Portable fundus photograph.
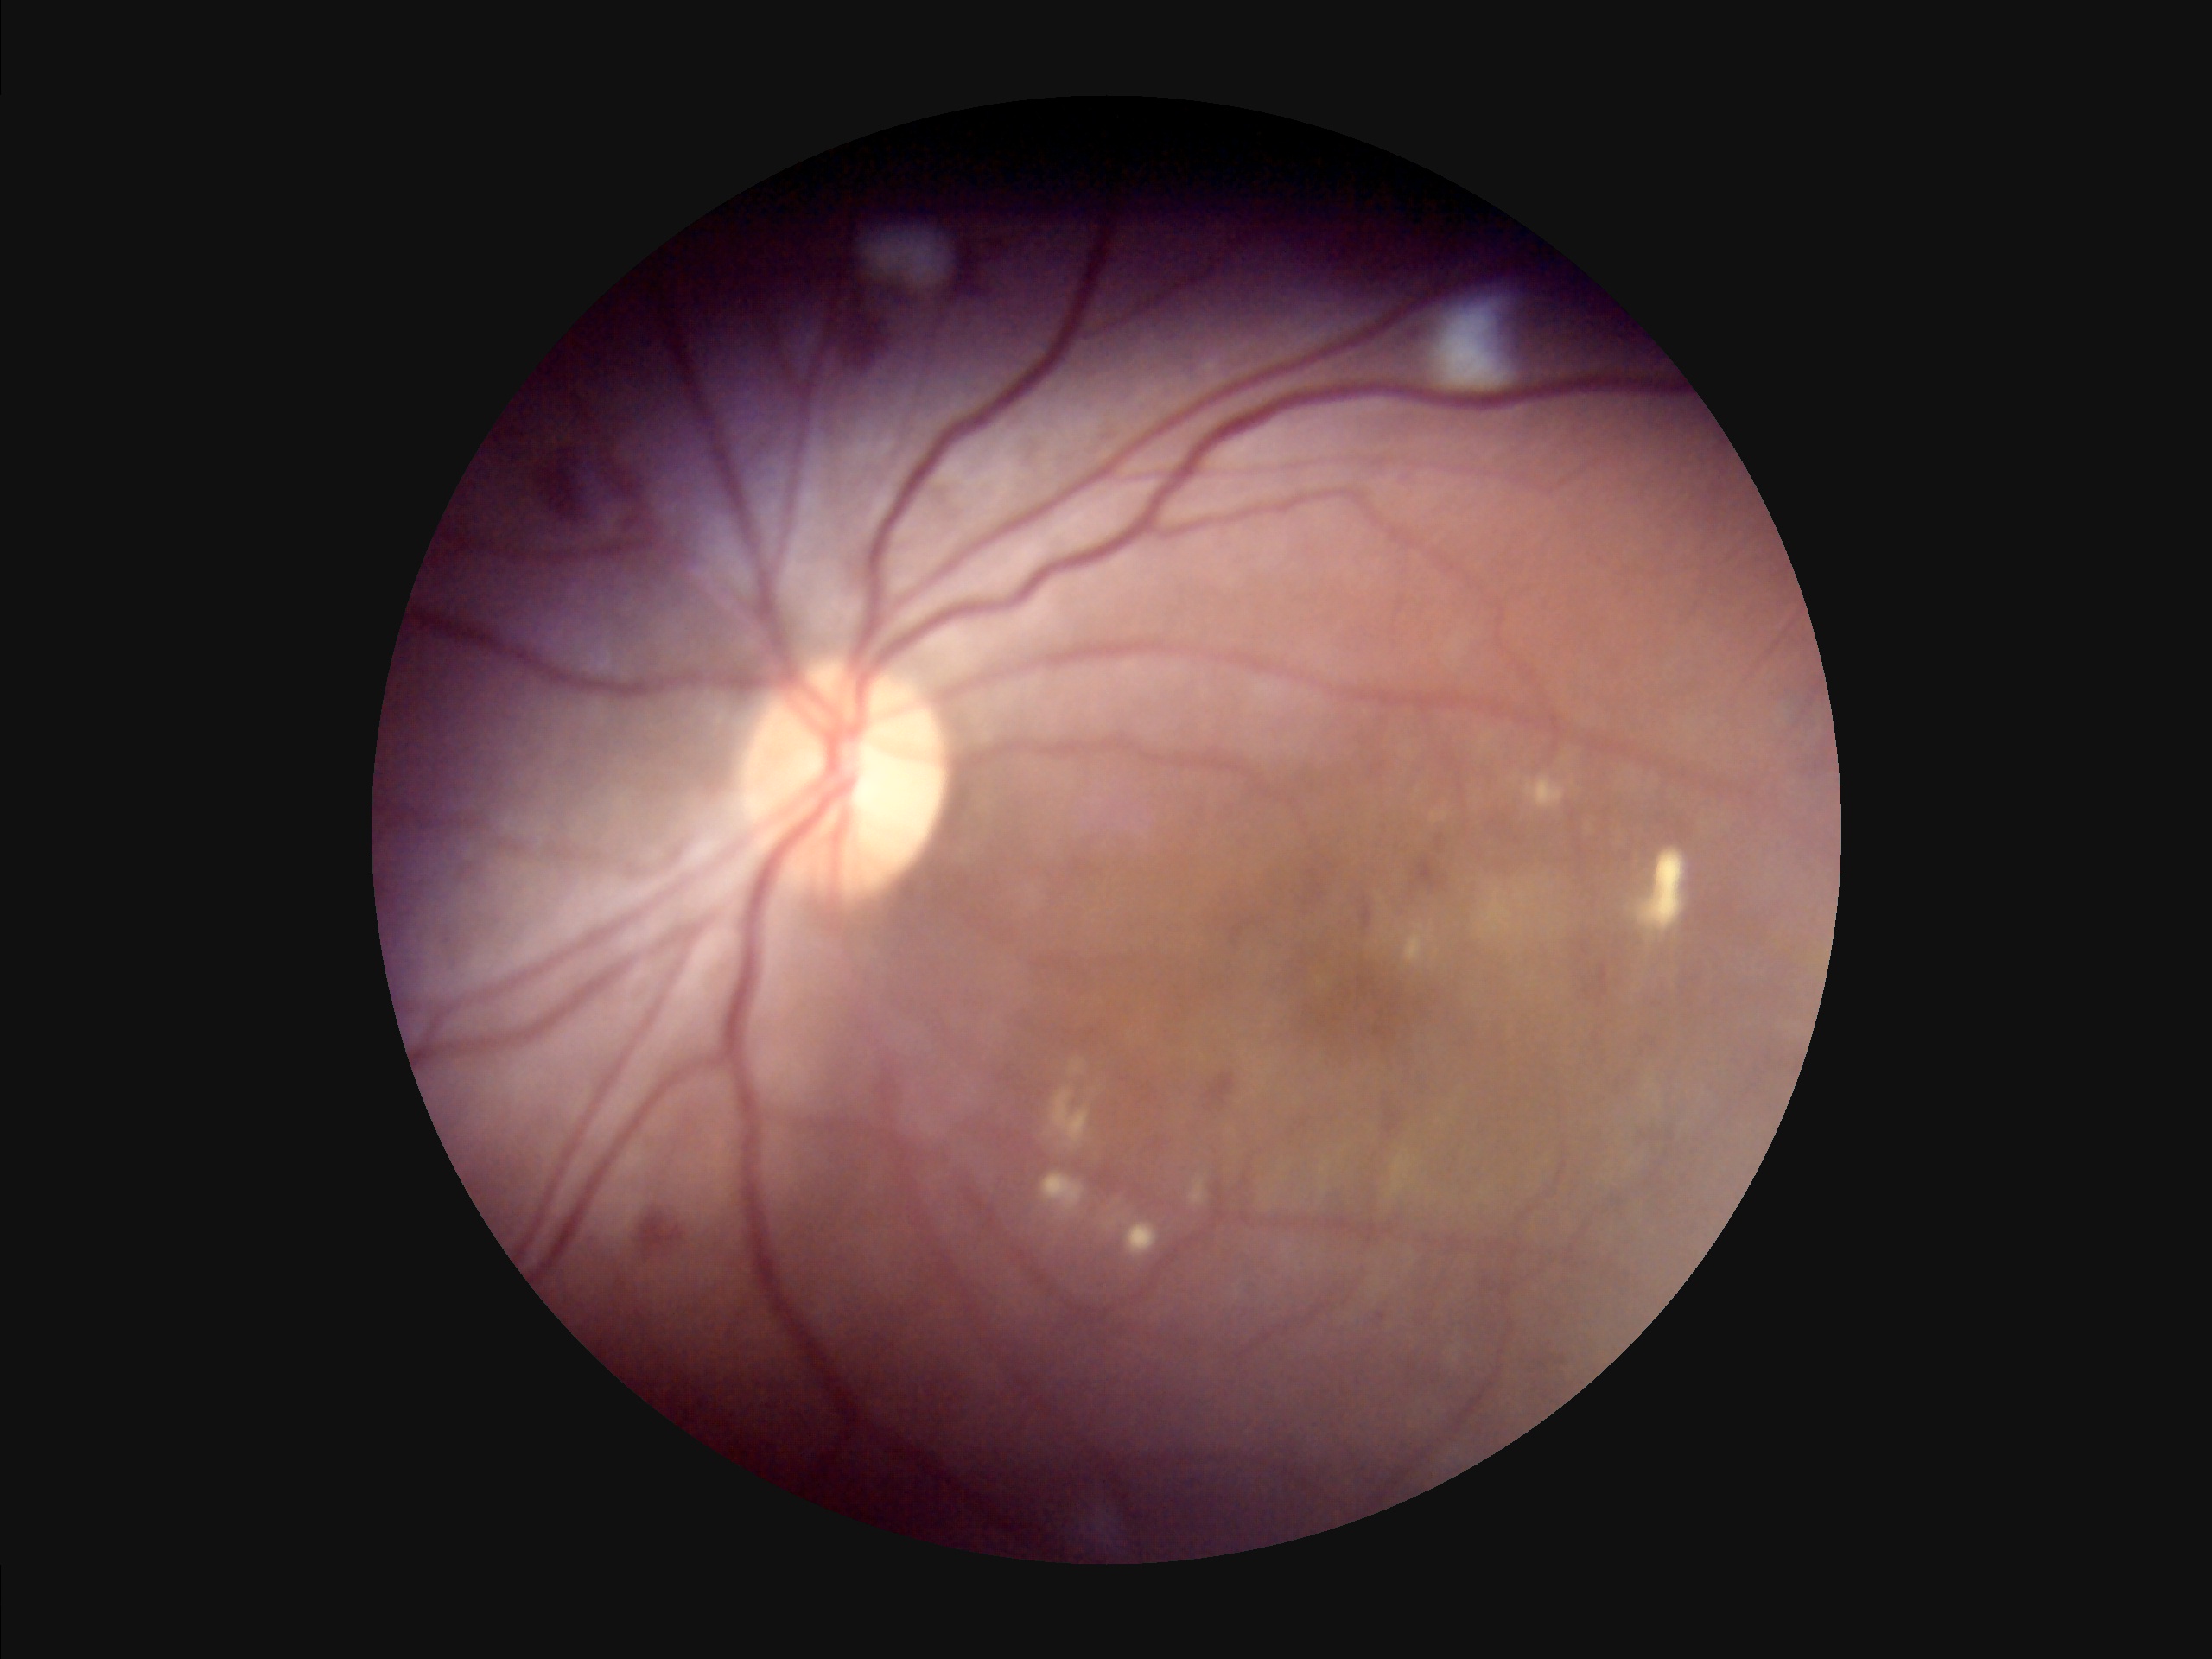
Overall image quality is poor. No noticeable blur. Narrow intensity range; structures are hard to distinguish. Illumination is uneven.